No pharmacologic dilation, modified Davis grading, NIDEK AFC-230 fundus camera, 848 x 848 pixels, retinal fundus photograph.
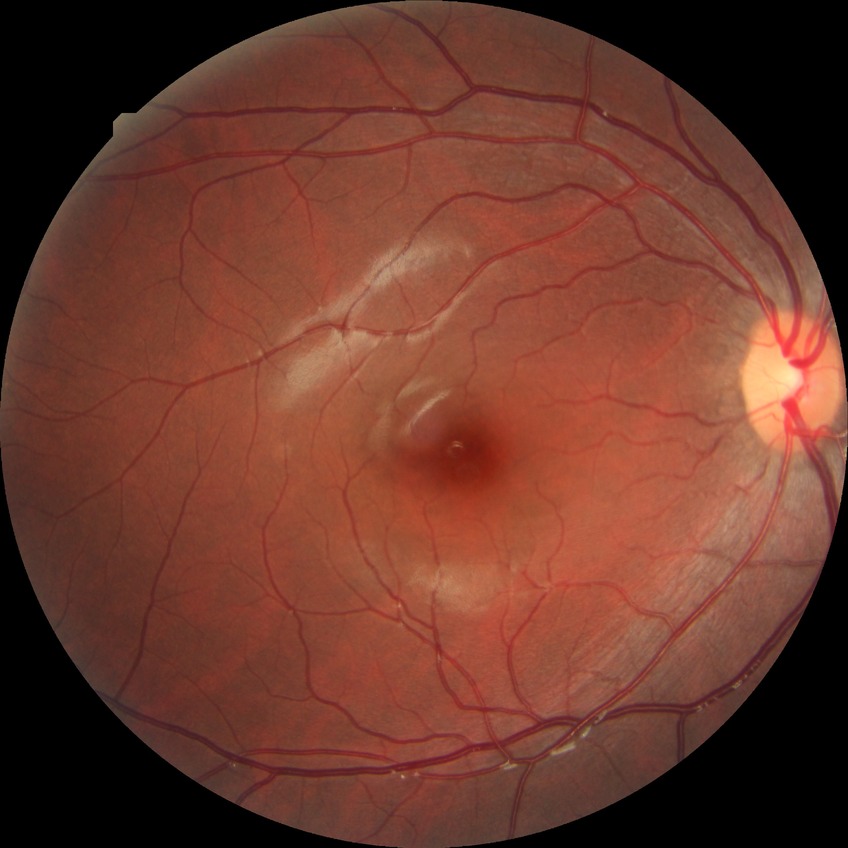
diabetic retinopathy (DR)=no diabetic retinopathy (NDR).